Captured on a Topcon TRC-NW8 fundus camera · 50-degree field of view: 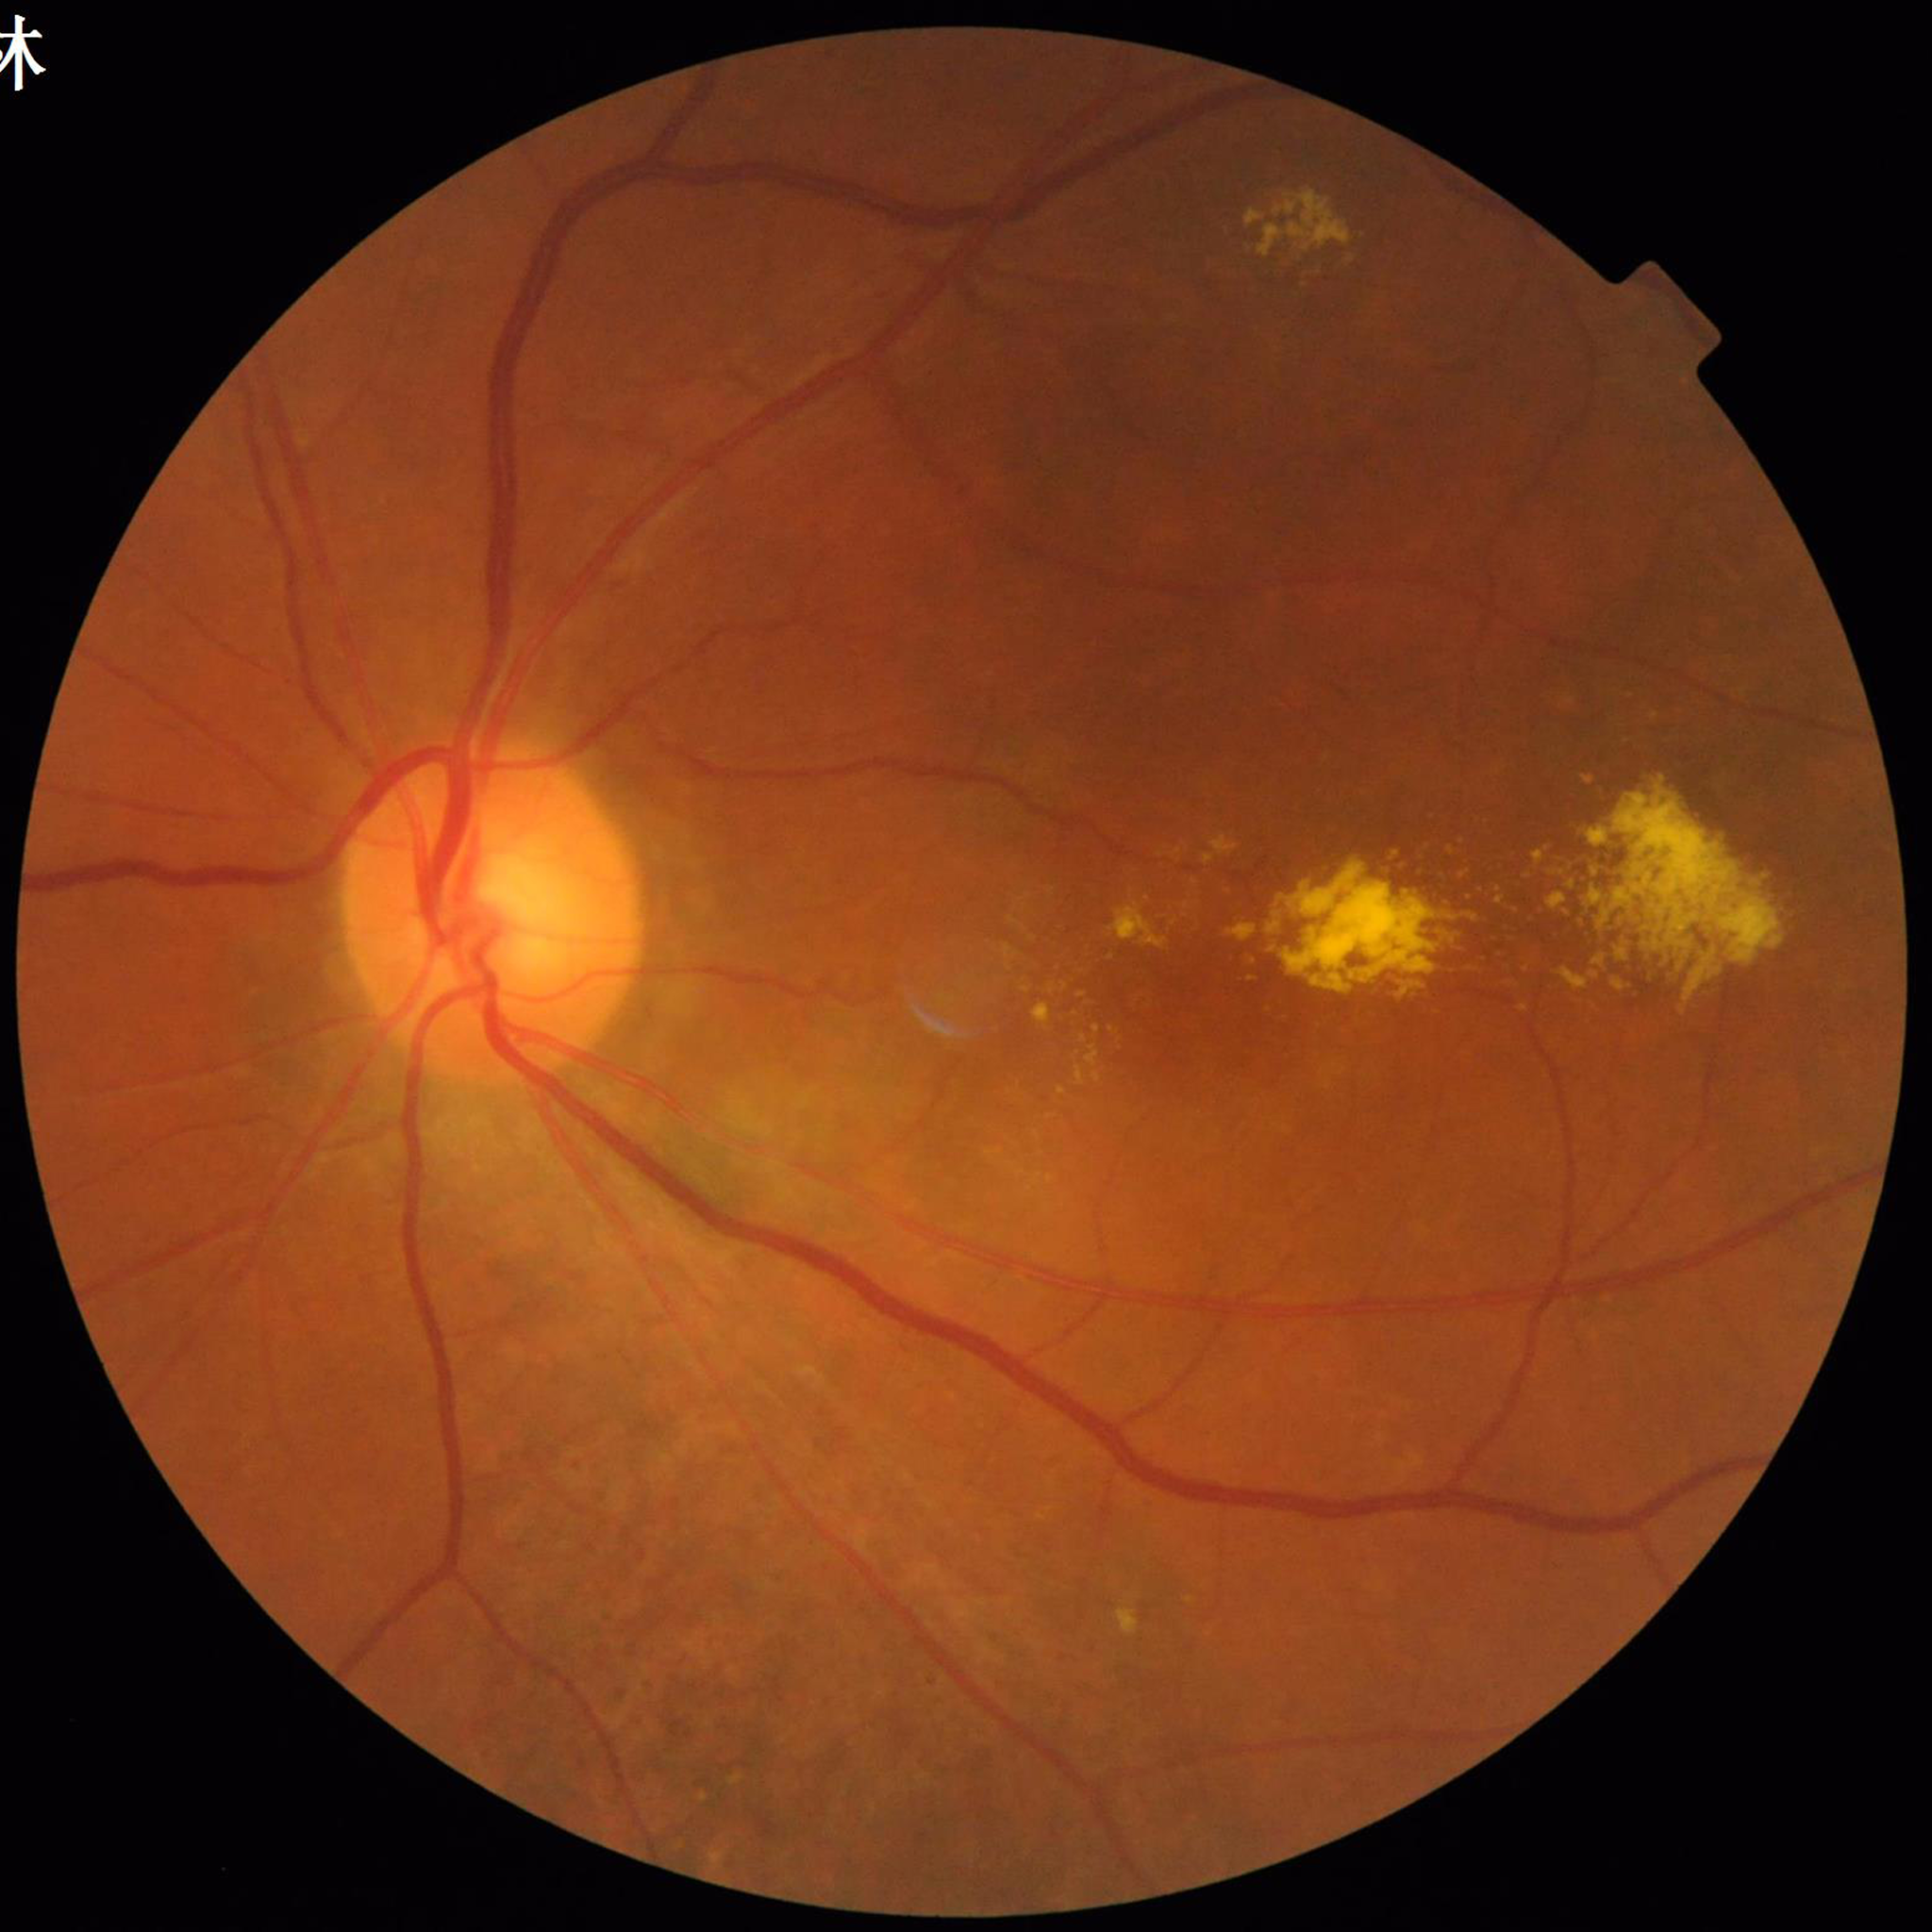 {
  "diagnosis": "age-related macular degeneration"
}